Retinal fundus photograph: 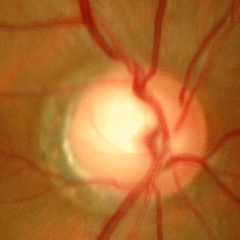
Glaucoma stage: no signs of glaucoma.